Nidek AFC-330: 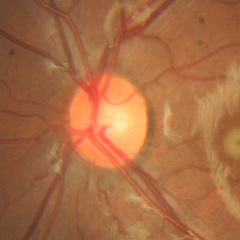 Demonstrates no glaucomatous optic neuropathy.